Wide-field fundus photograph from neonatal ROP screening; 130° field of view (Natus RetCam Envision).
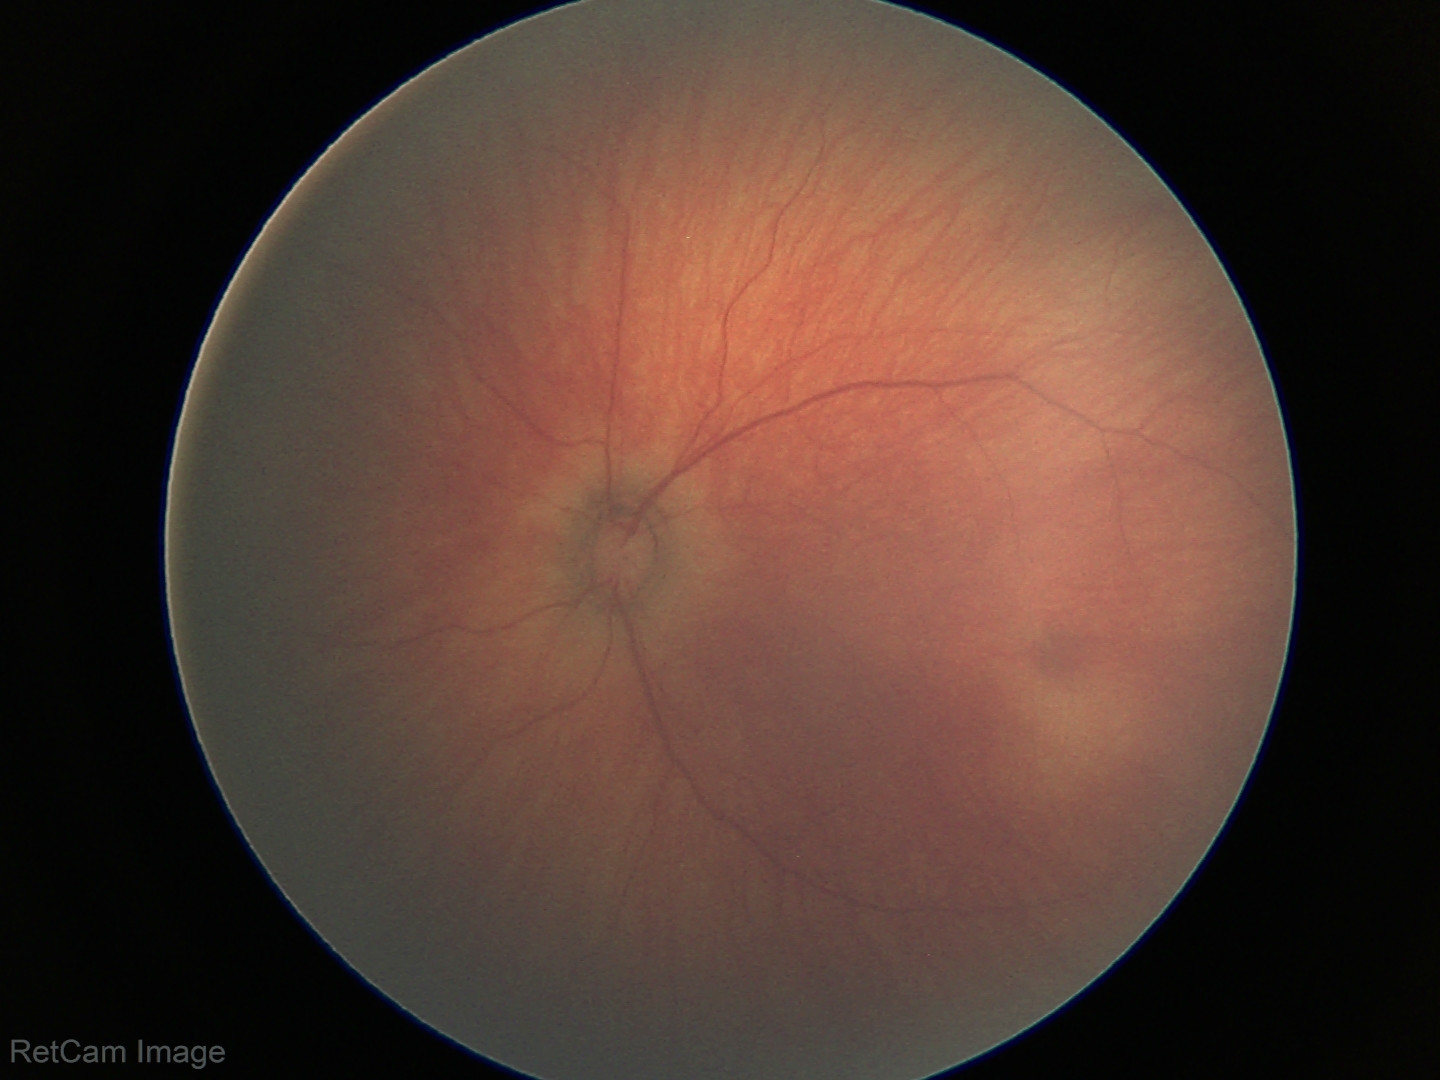

Q: What was the screening finding?
A: physiological retinal finding